240 x 240 pixels · camera: Nidek AFC-330 · color fundus image:
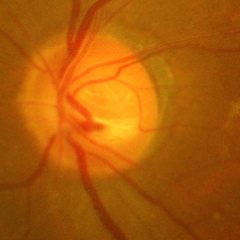
Assessment: advanced glaucomatous optic neuropathy.